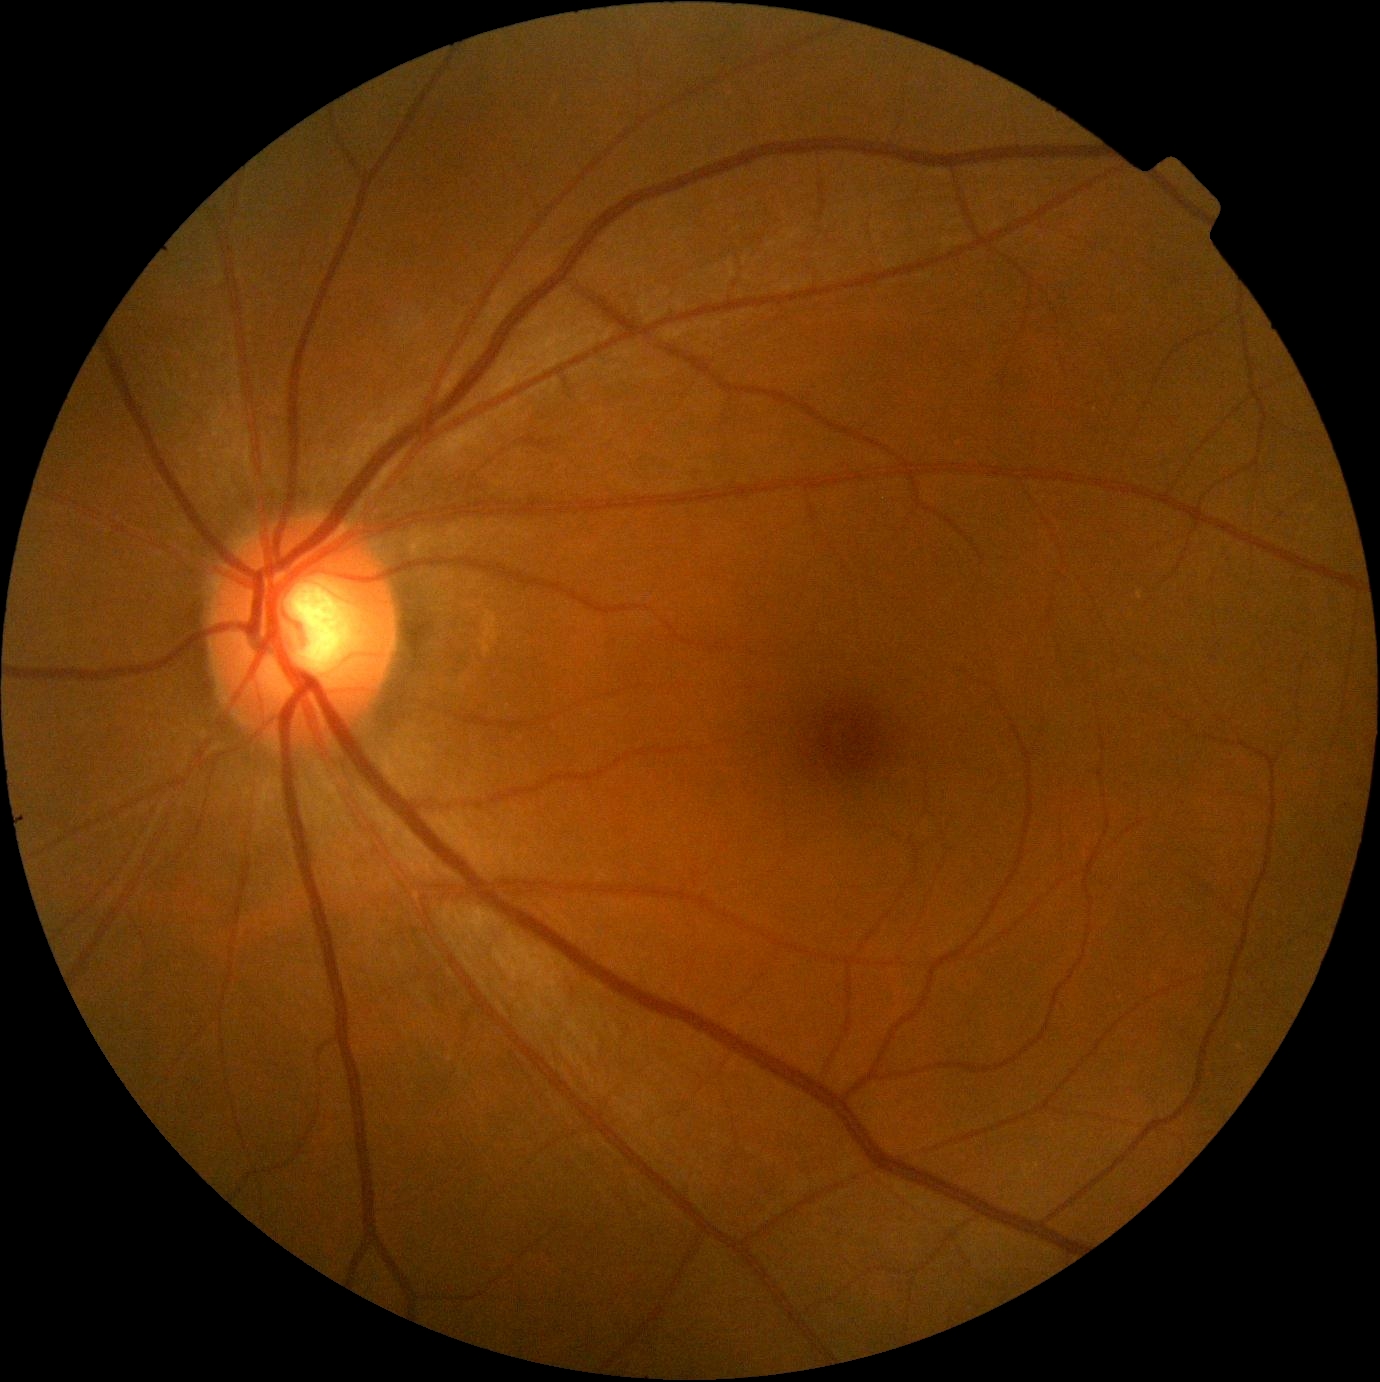
{
  "dr_grade": "no apparent diabetic retinopathy (grade 0)",
  "dr_impression": "no DR findings"
}